Diabetic retinopathy graded by the modified Davis classification: 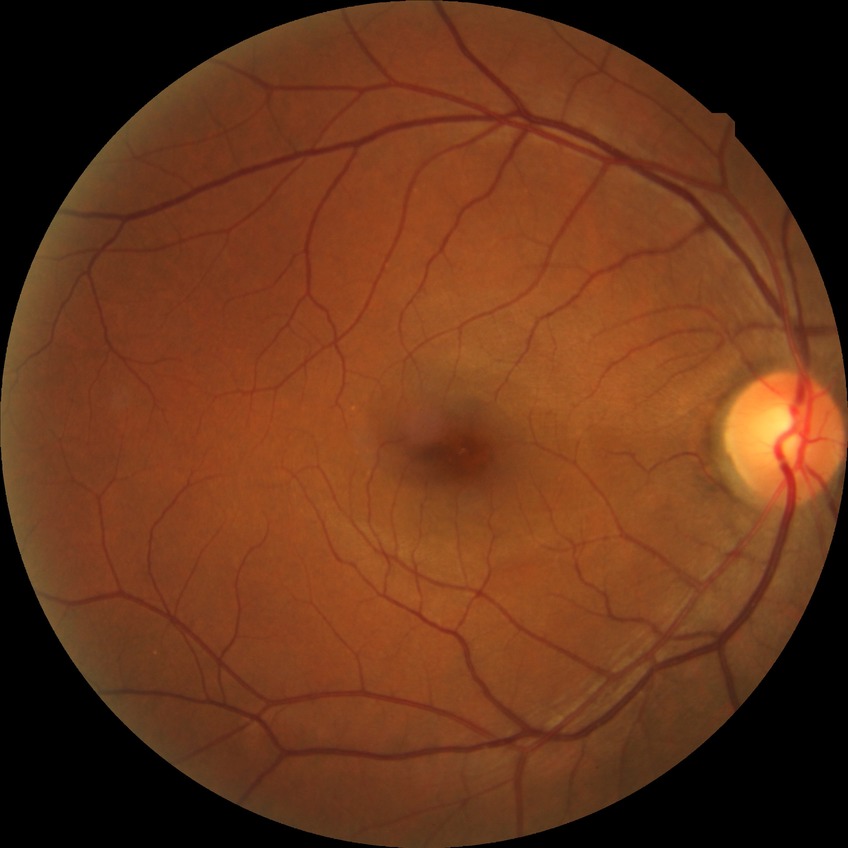
diabetic retinopathy (DR)=NDR (no diabetic retinopathy).